Acquired on the Phoenix ICON · 1240 x 1240 pixels · wide-field contact fundus photograph of an infant — 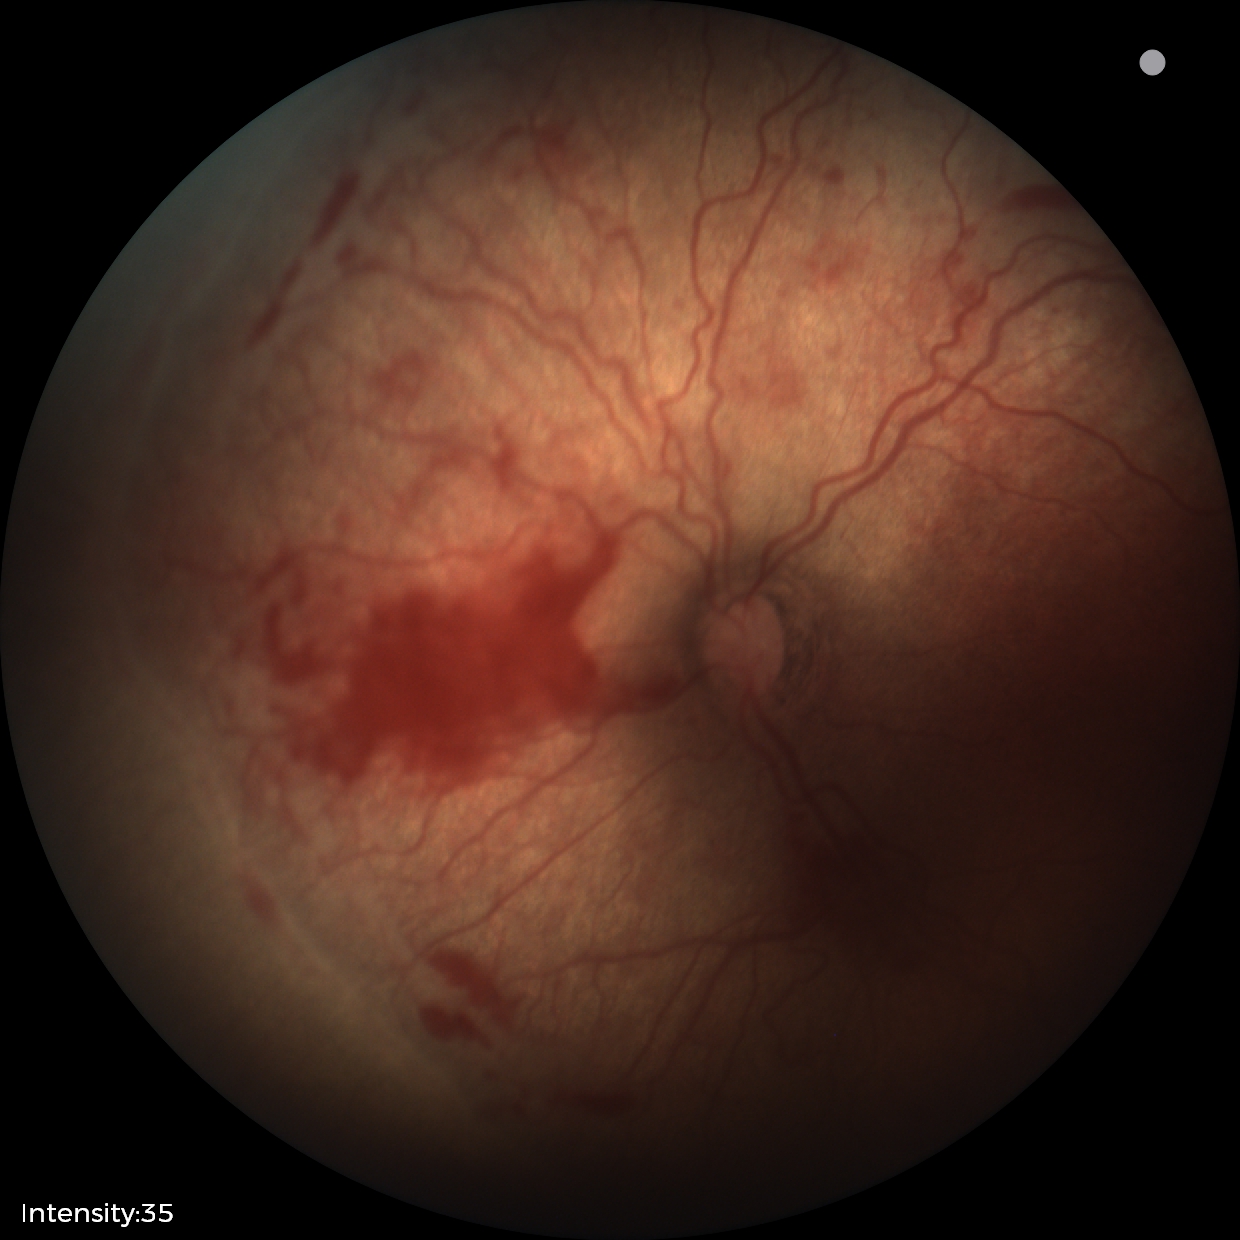 Q: Is plus disease present?
A: plus disease
Q: What is the screening diagnosis?
A: ROP stage 2